2212x1659px; 45-degree field of view; color fundus photograph
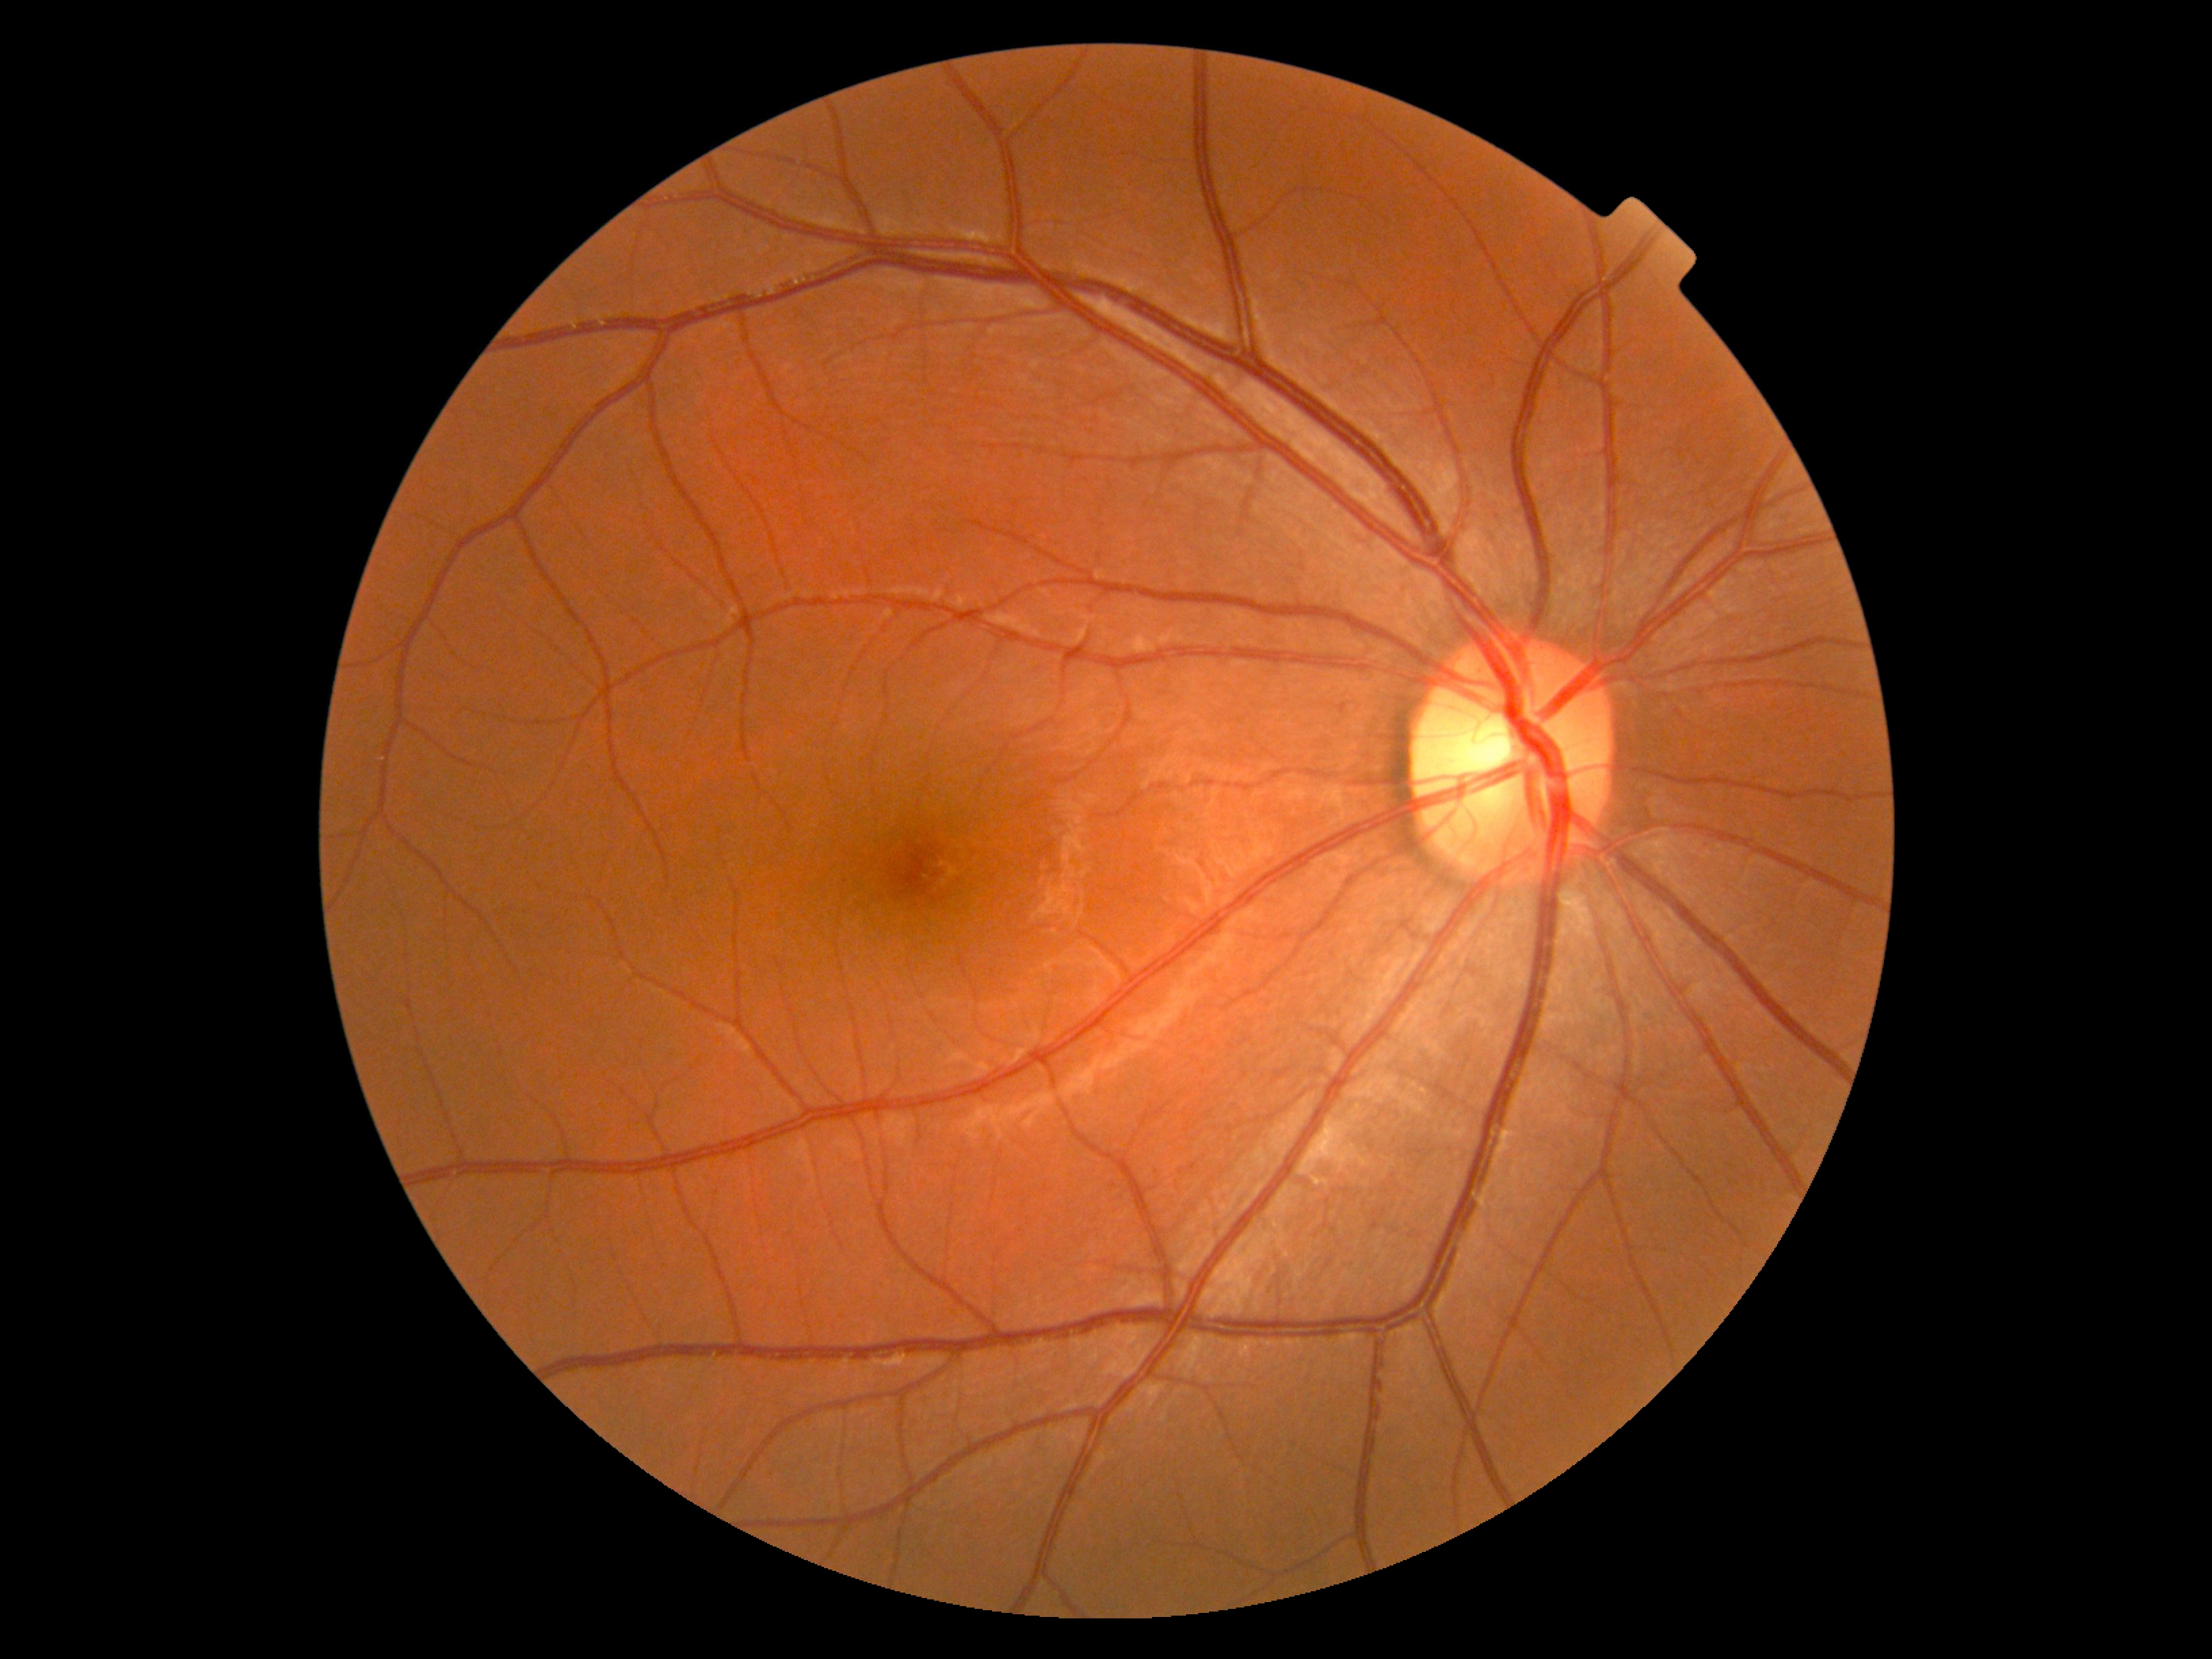

DR severity is no apparent retinopathy (grade 0).